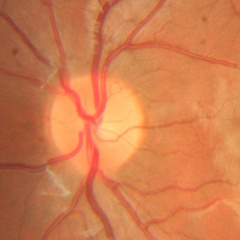

No evidence of glaucoma.